45 degree fundus photograph; no pharmacologic dilation; Davis DR grading.
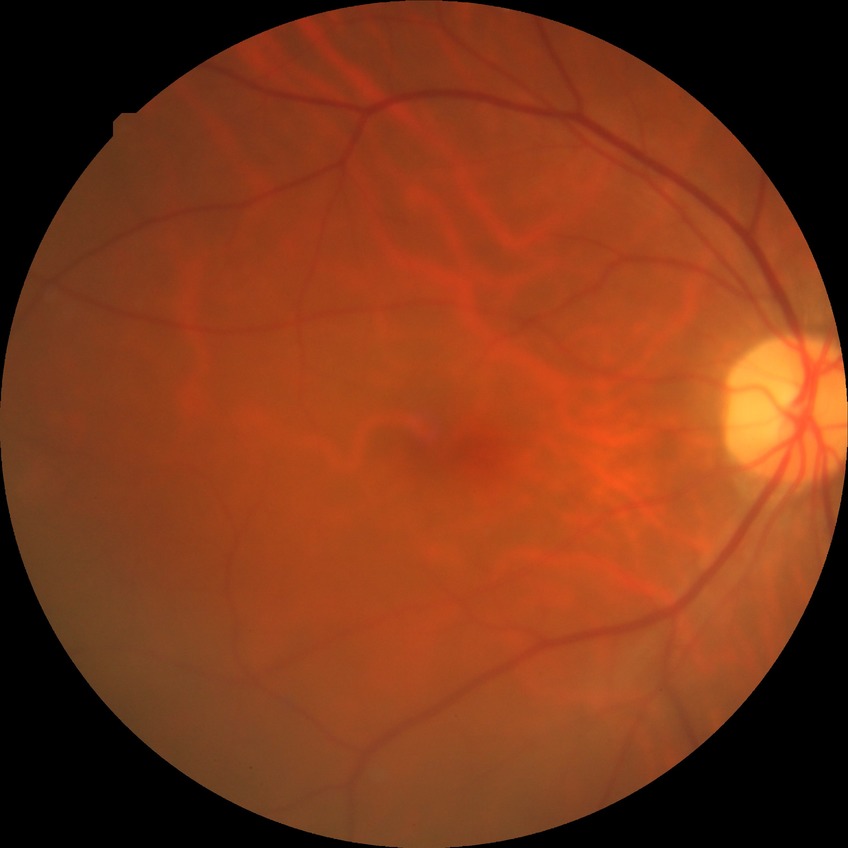

retinopathy stage: no diabetic retinopathy